NIDEK AFC-230.
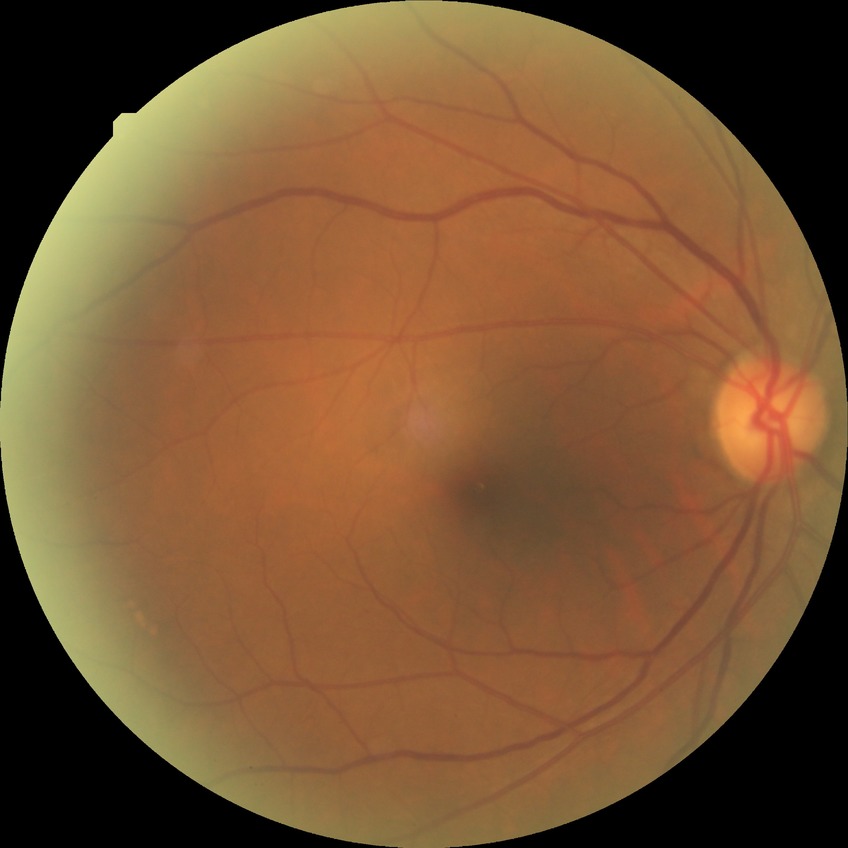
Findings:
• modified Davis grade: NDR